45° FOV: 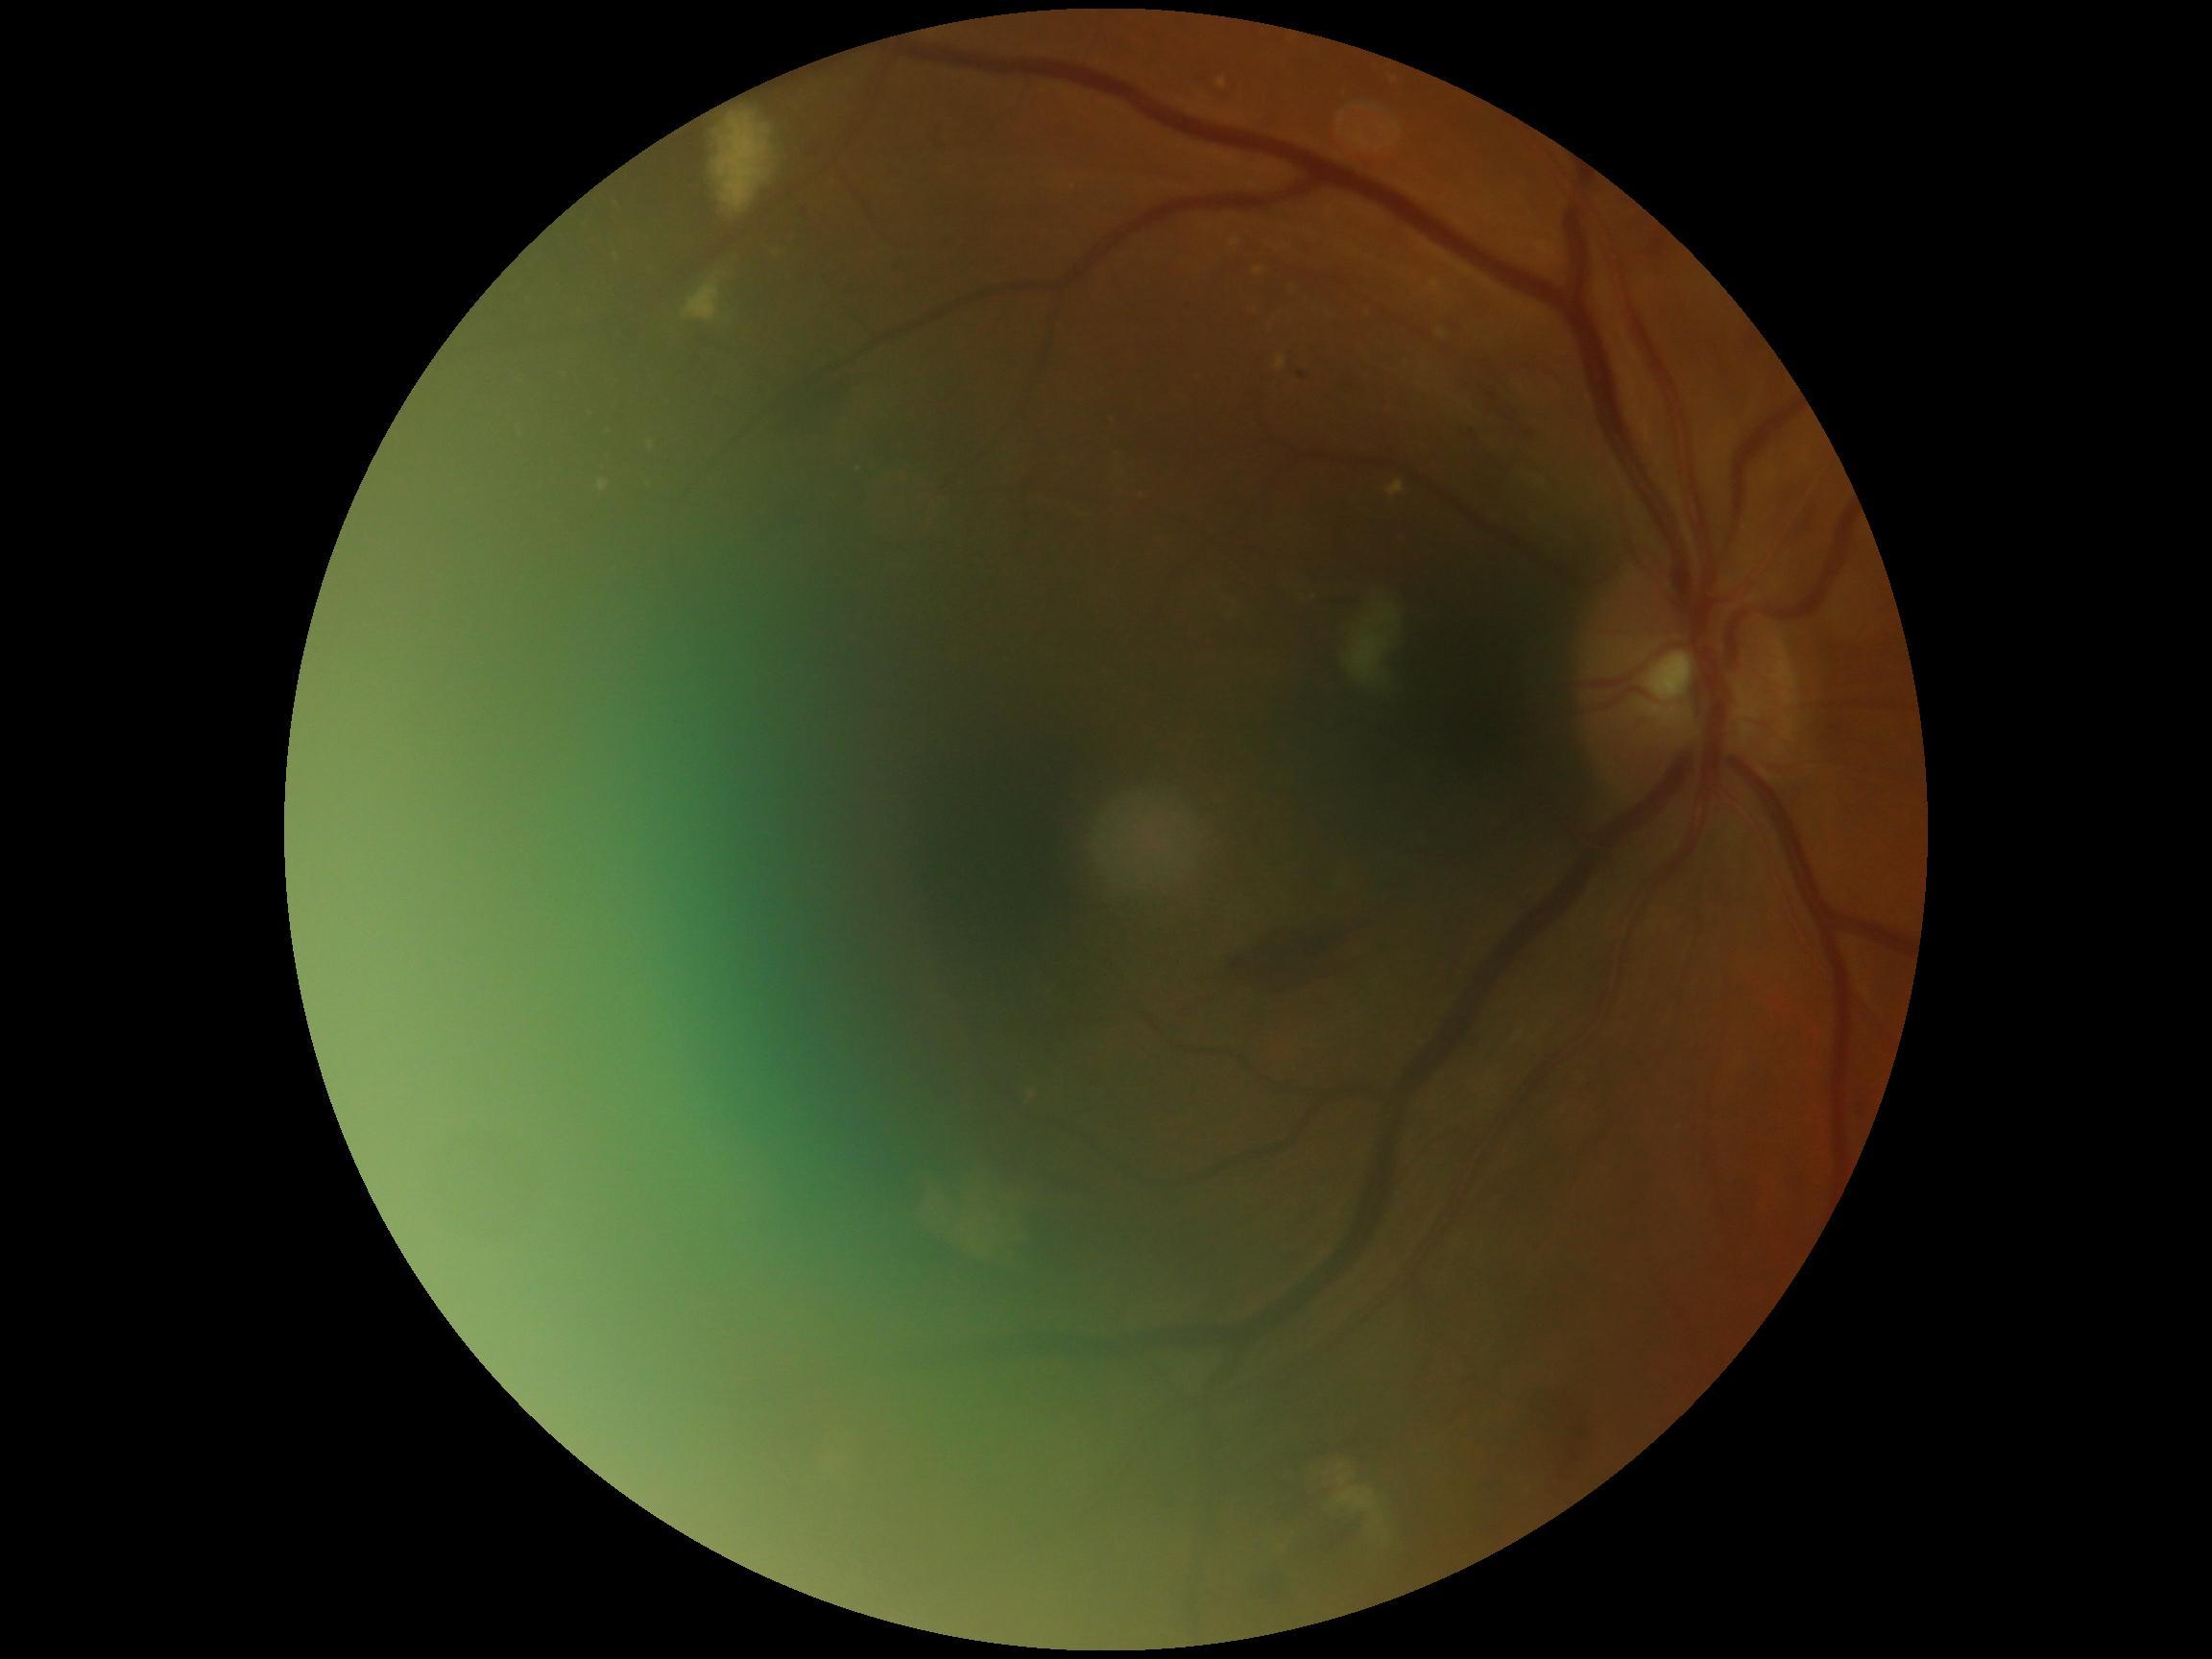
DR is moderate NPDR (grade 2).